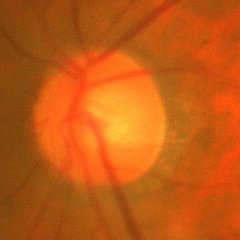 Glaucoma assessment: early glaucomatous changes.